CFP
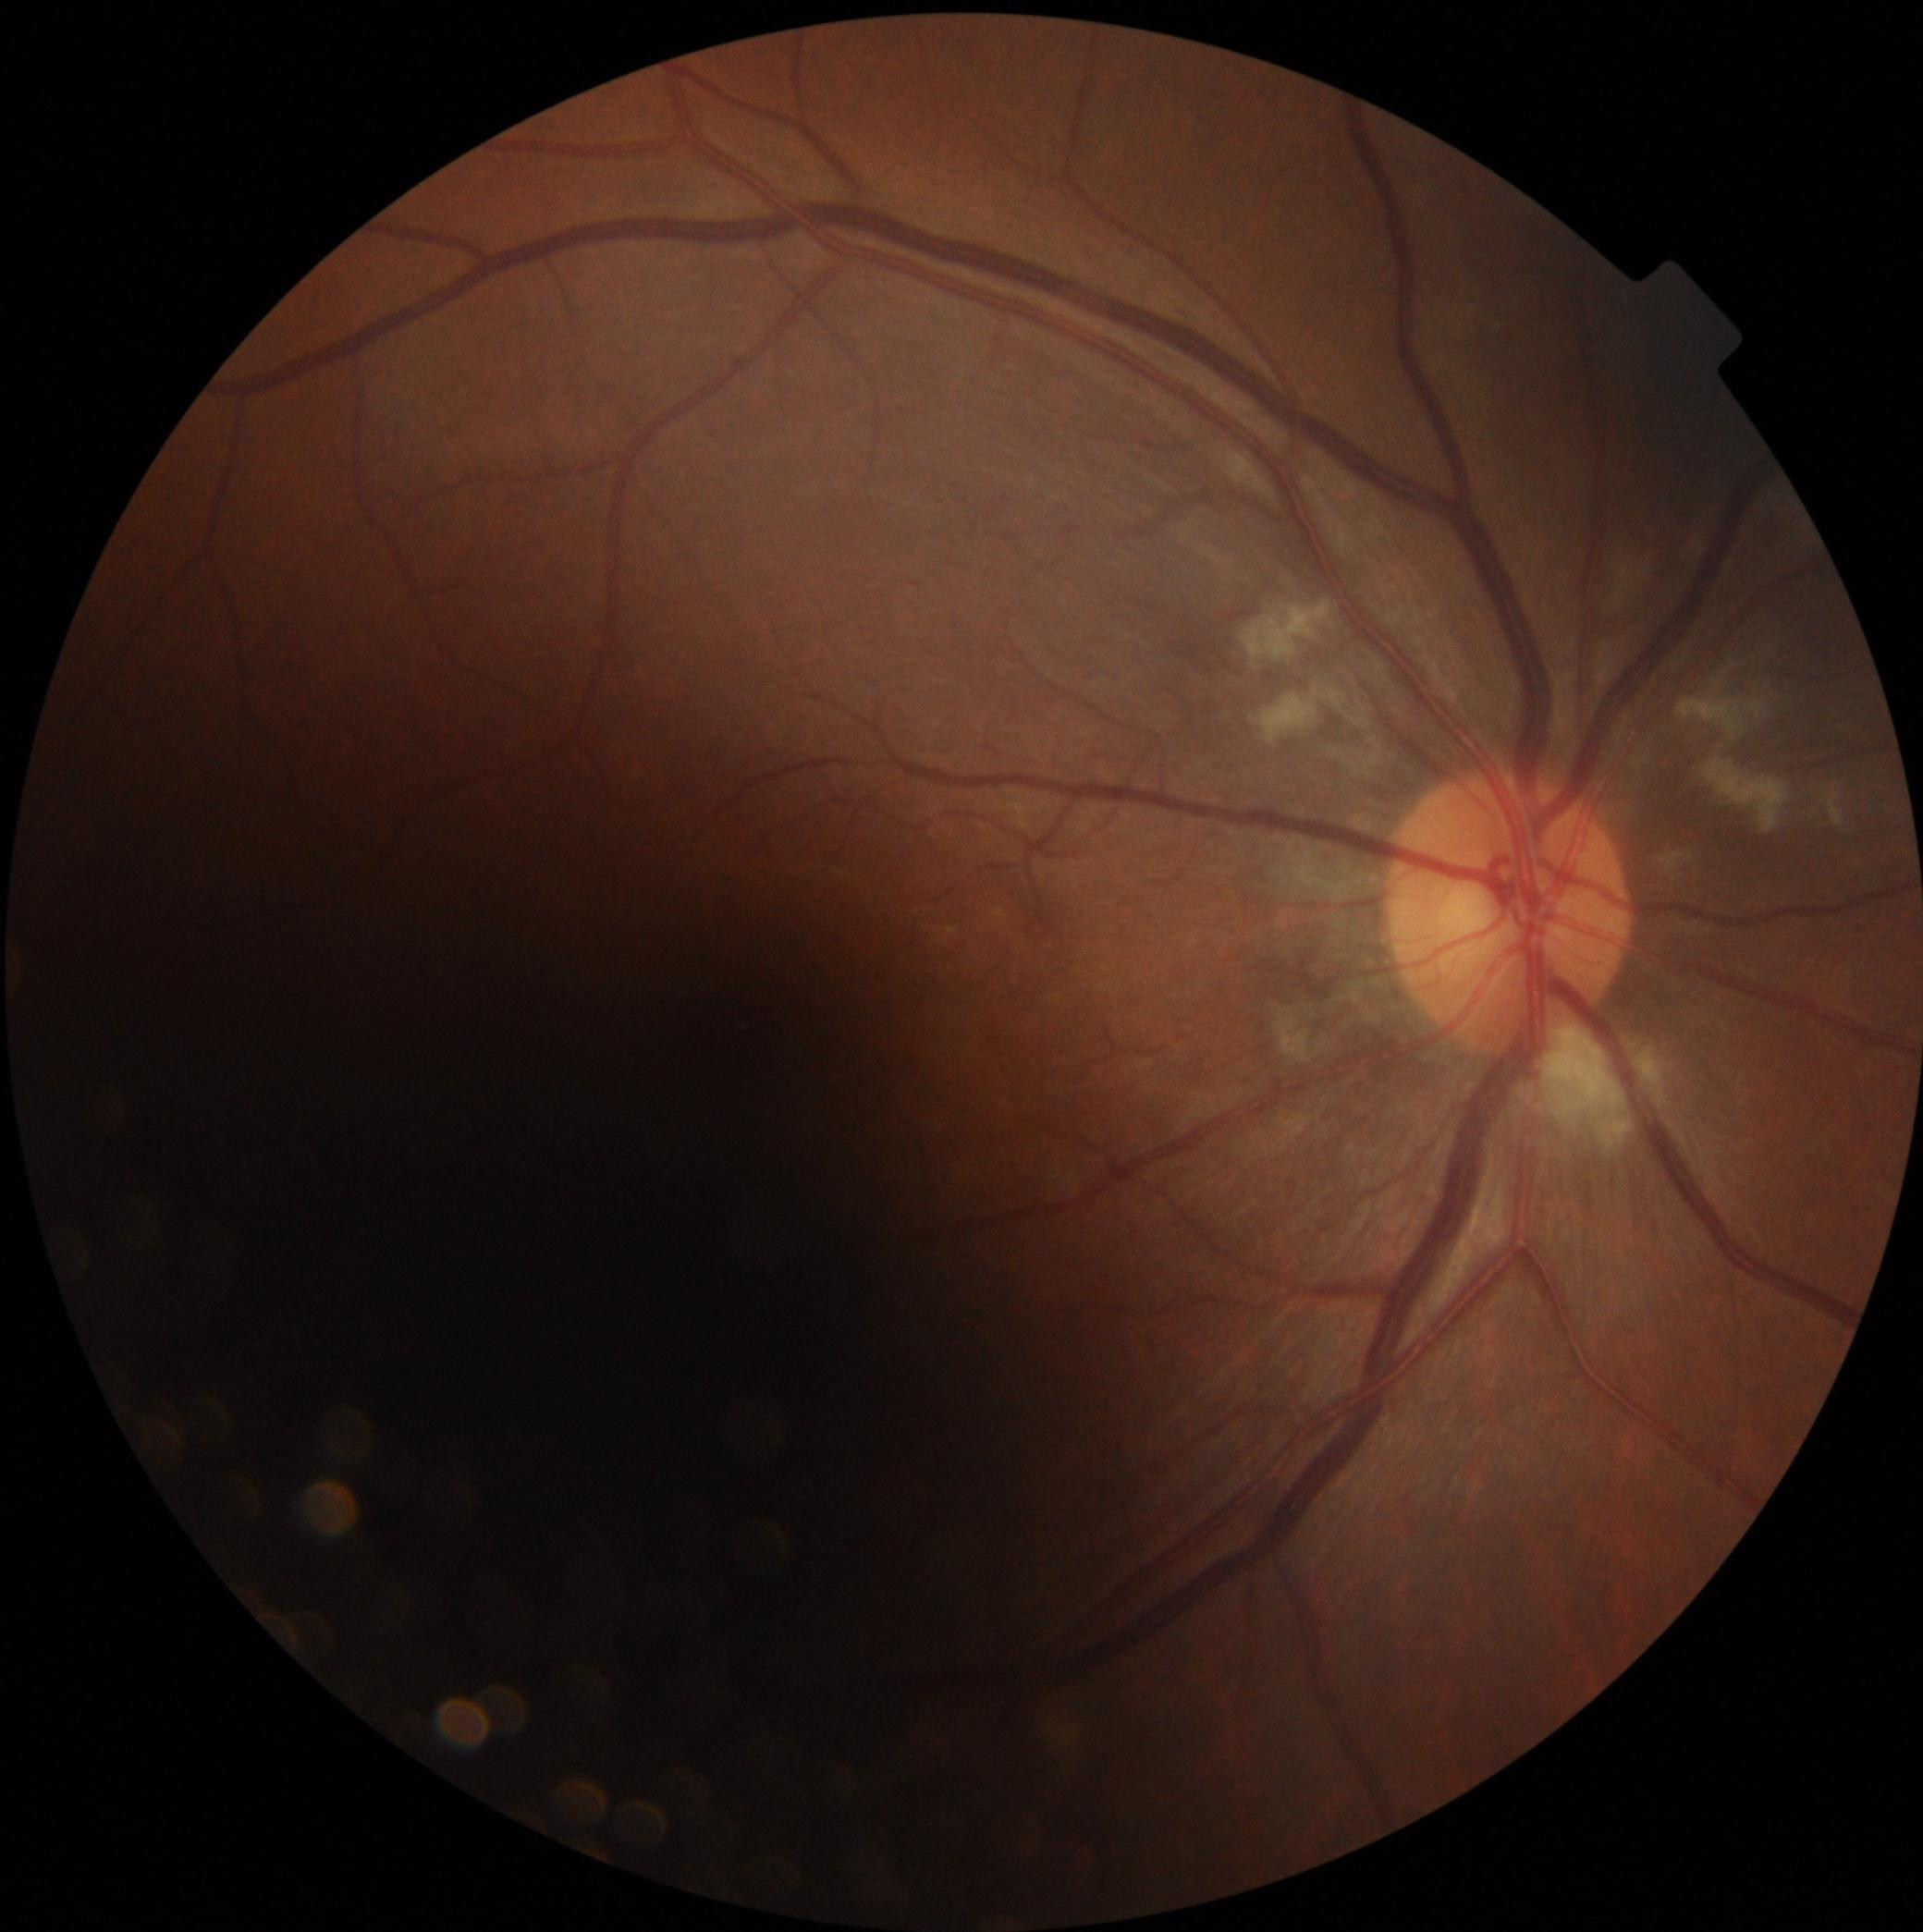

Diabetic retinopathy (DR) is 2/4.